Nonmydriatic; 45-degree field of view; acquired with a NIDEK AFC-230; 848 by 848 pixels
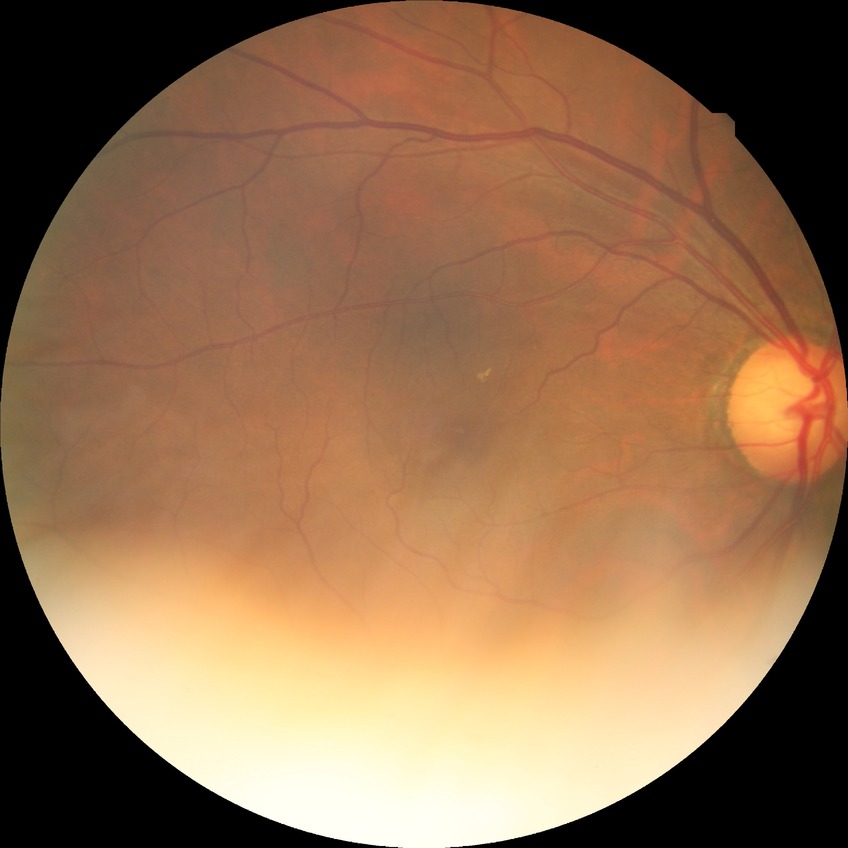
Davis grading: no diabetic retinopathy.